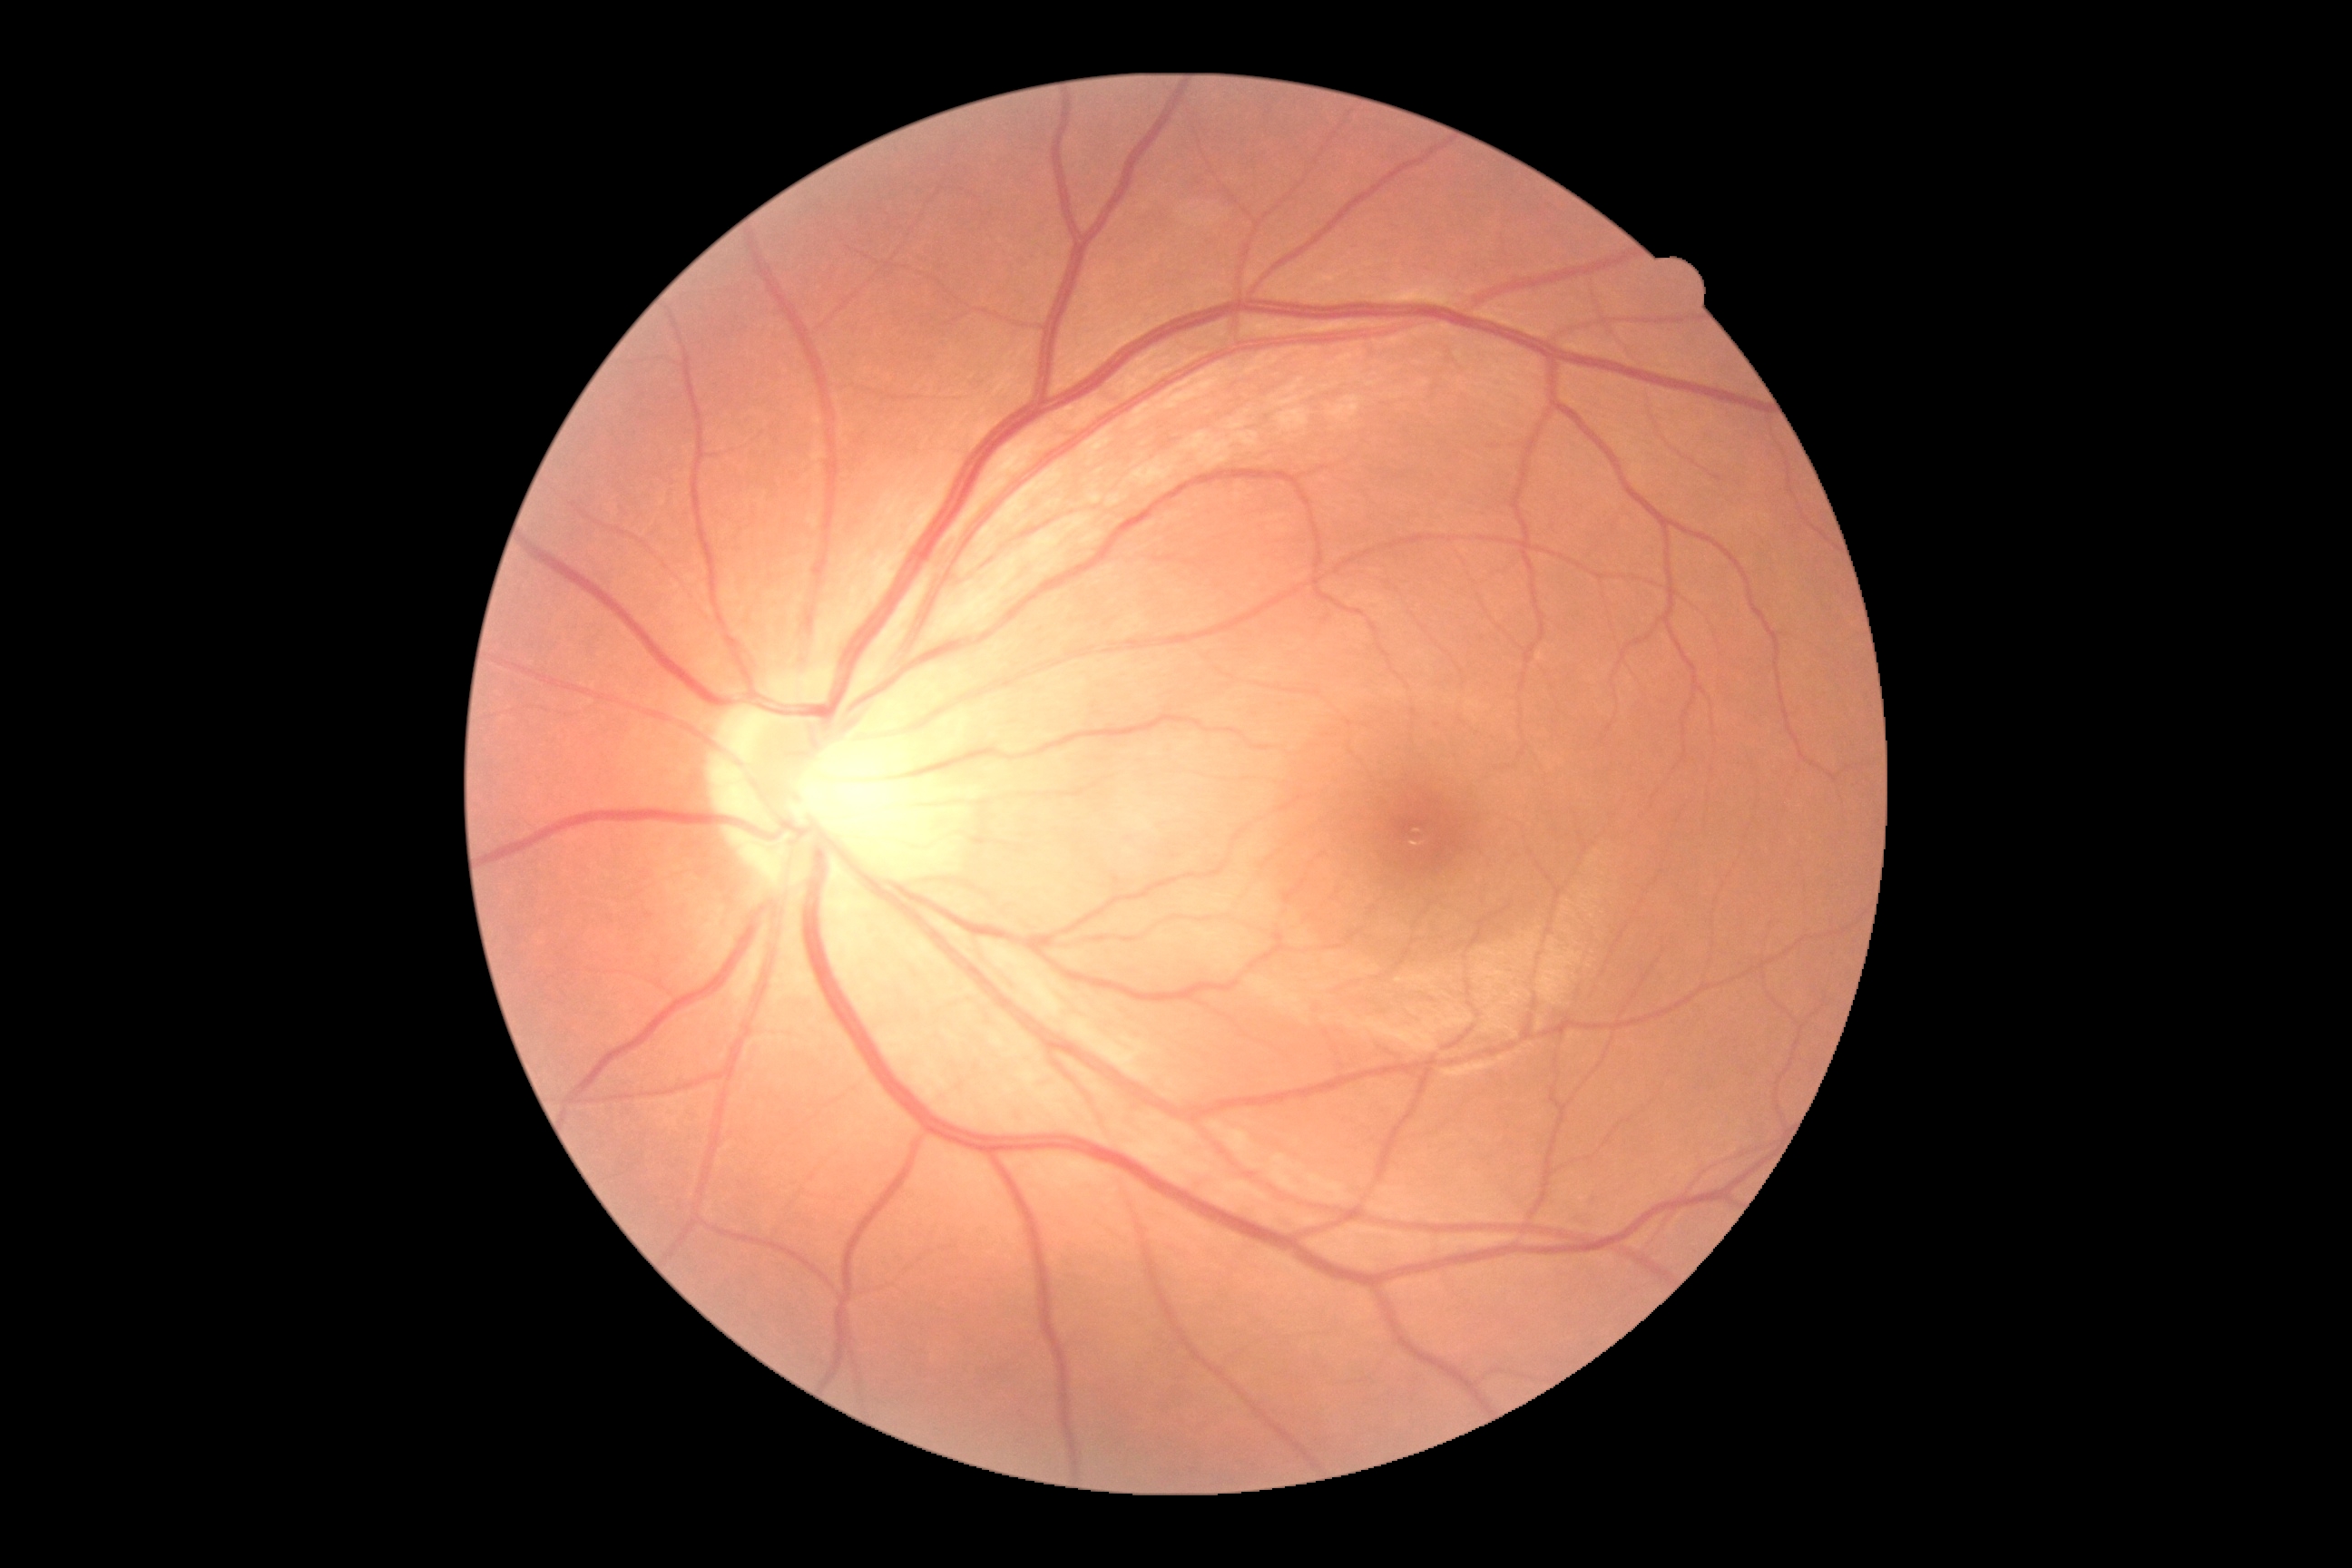
Diabetic retinopathy: 0/4.